Acquired with a Remidio smartphone fundus camera.
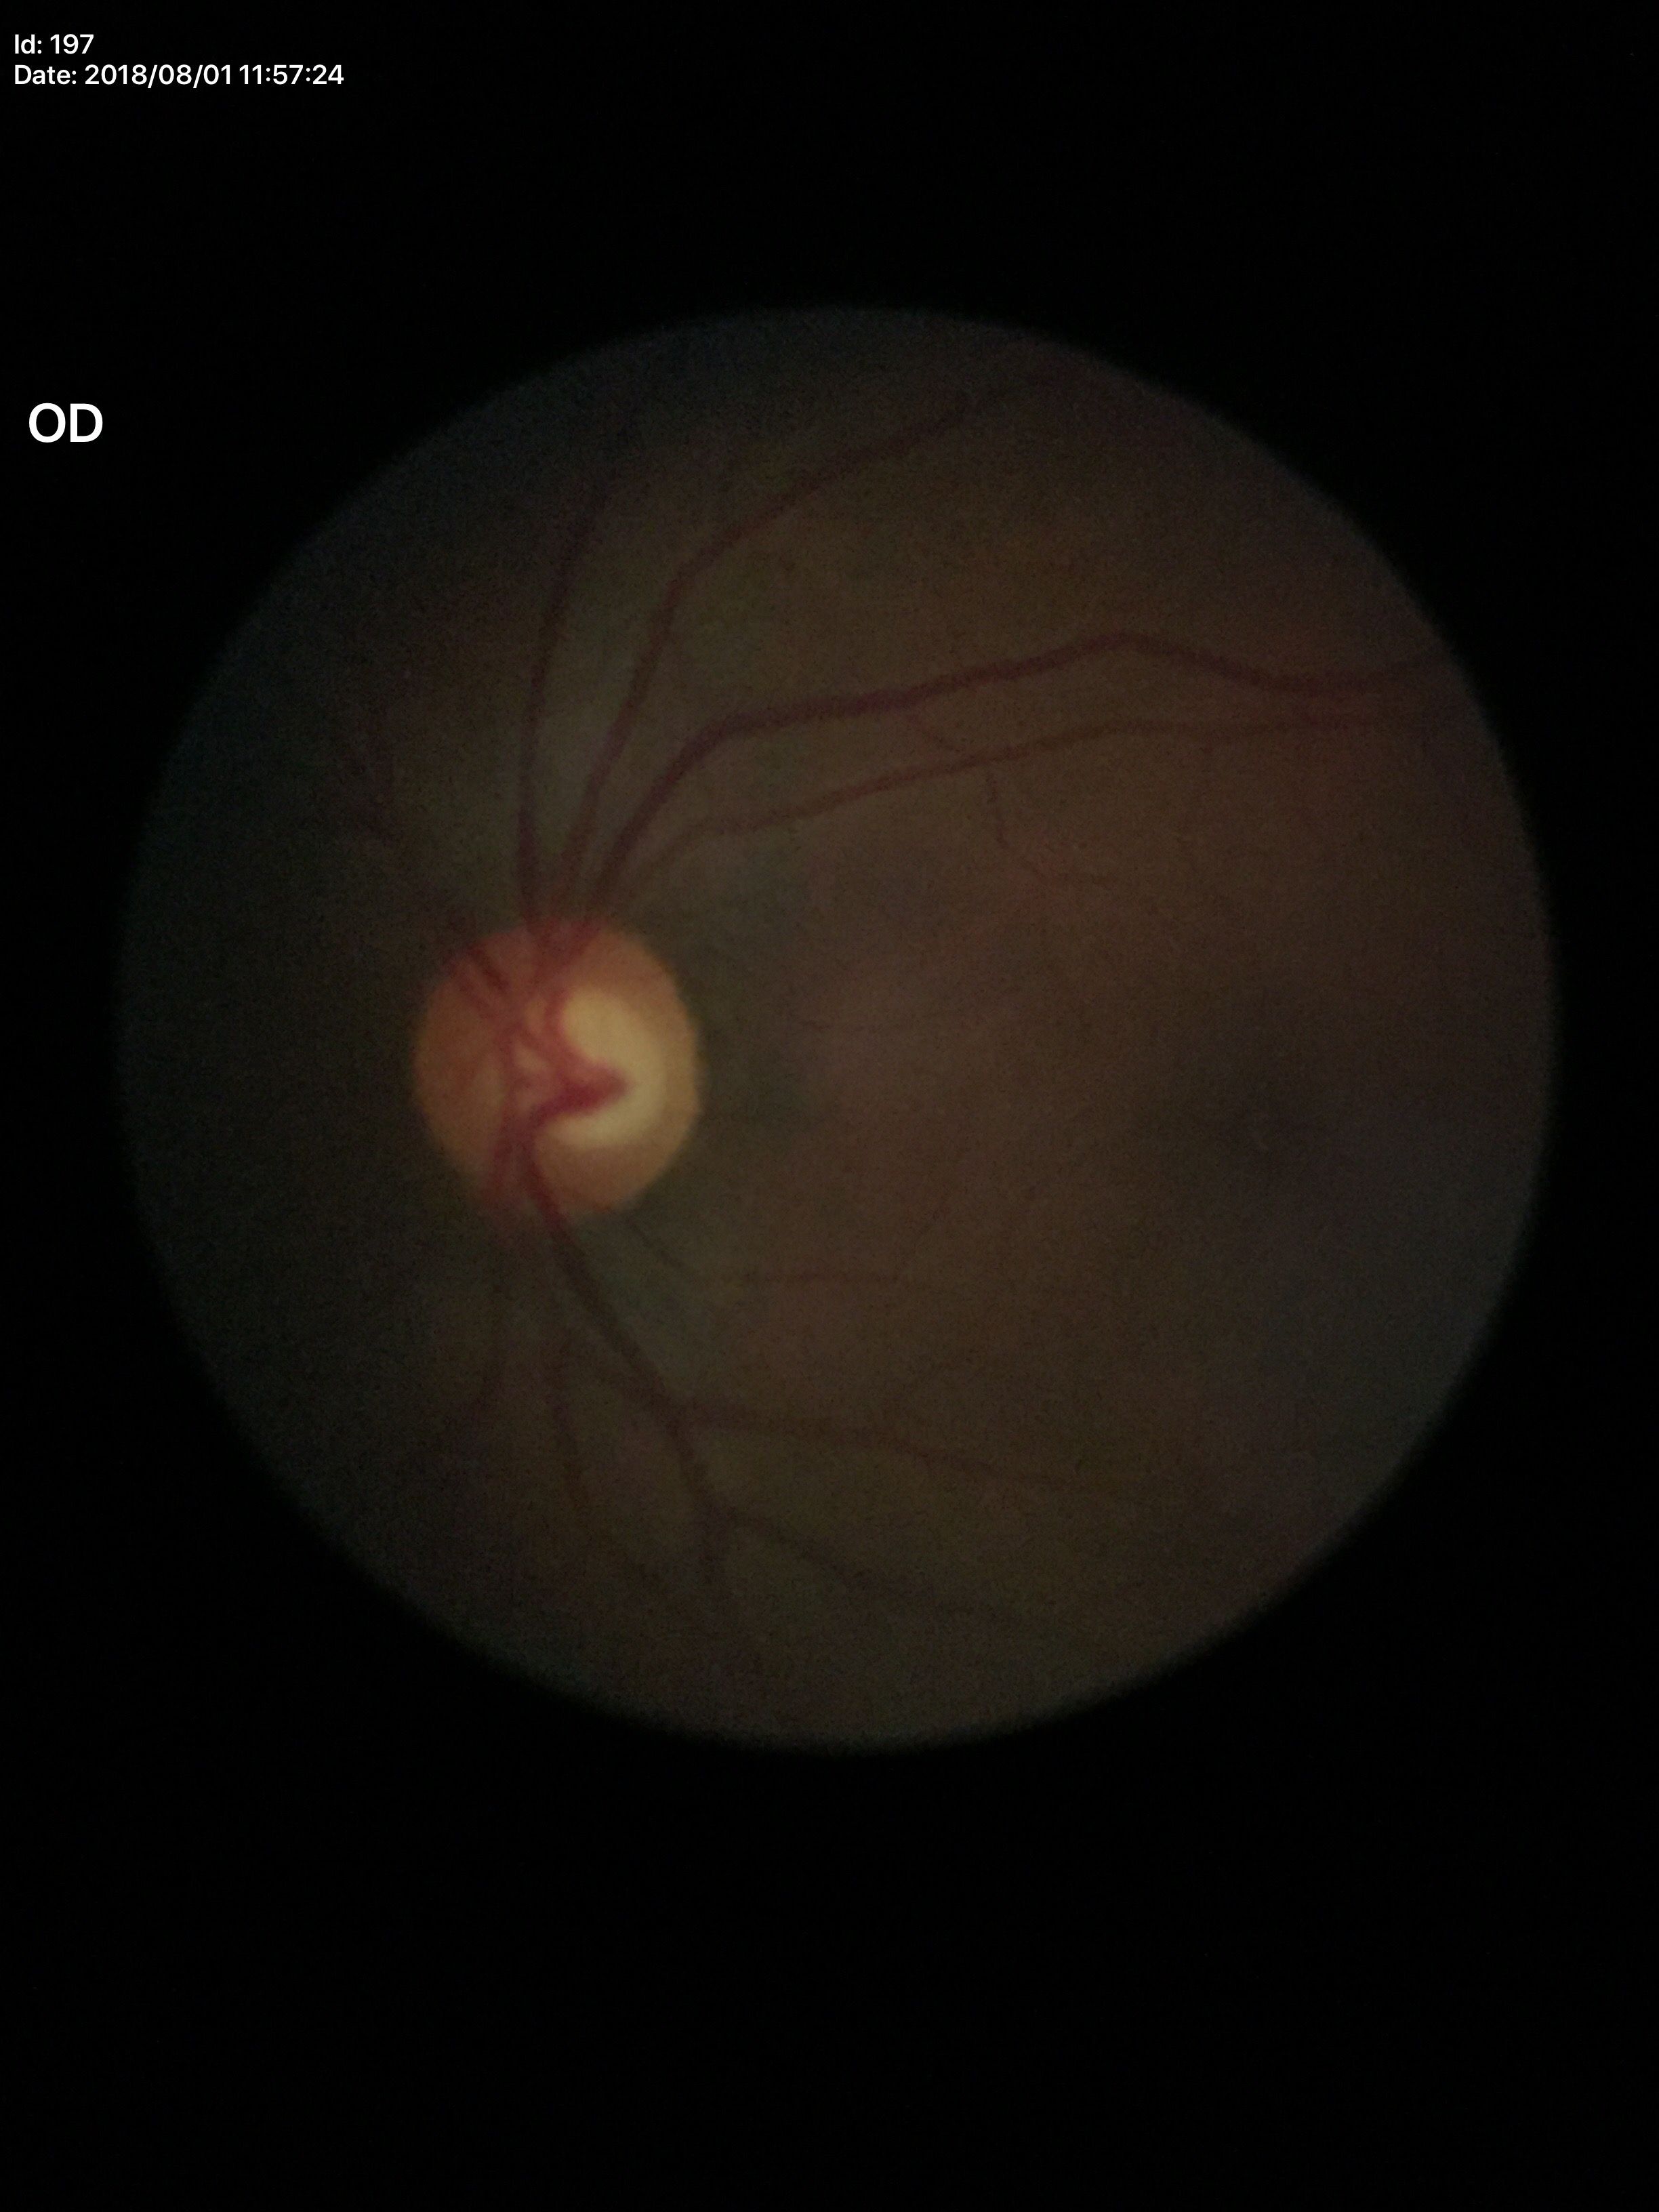

No glaucomatous optic neuropathy. Vertical CDR (VCDR) of 0.54.